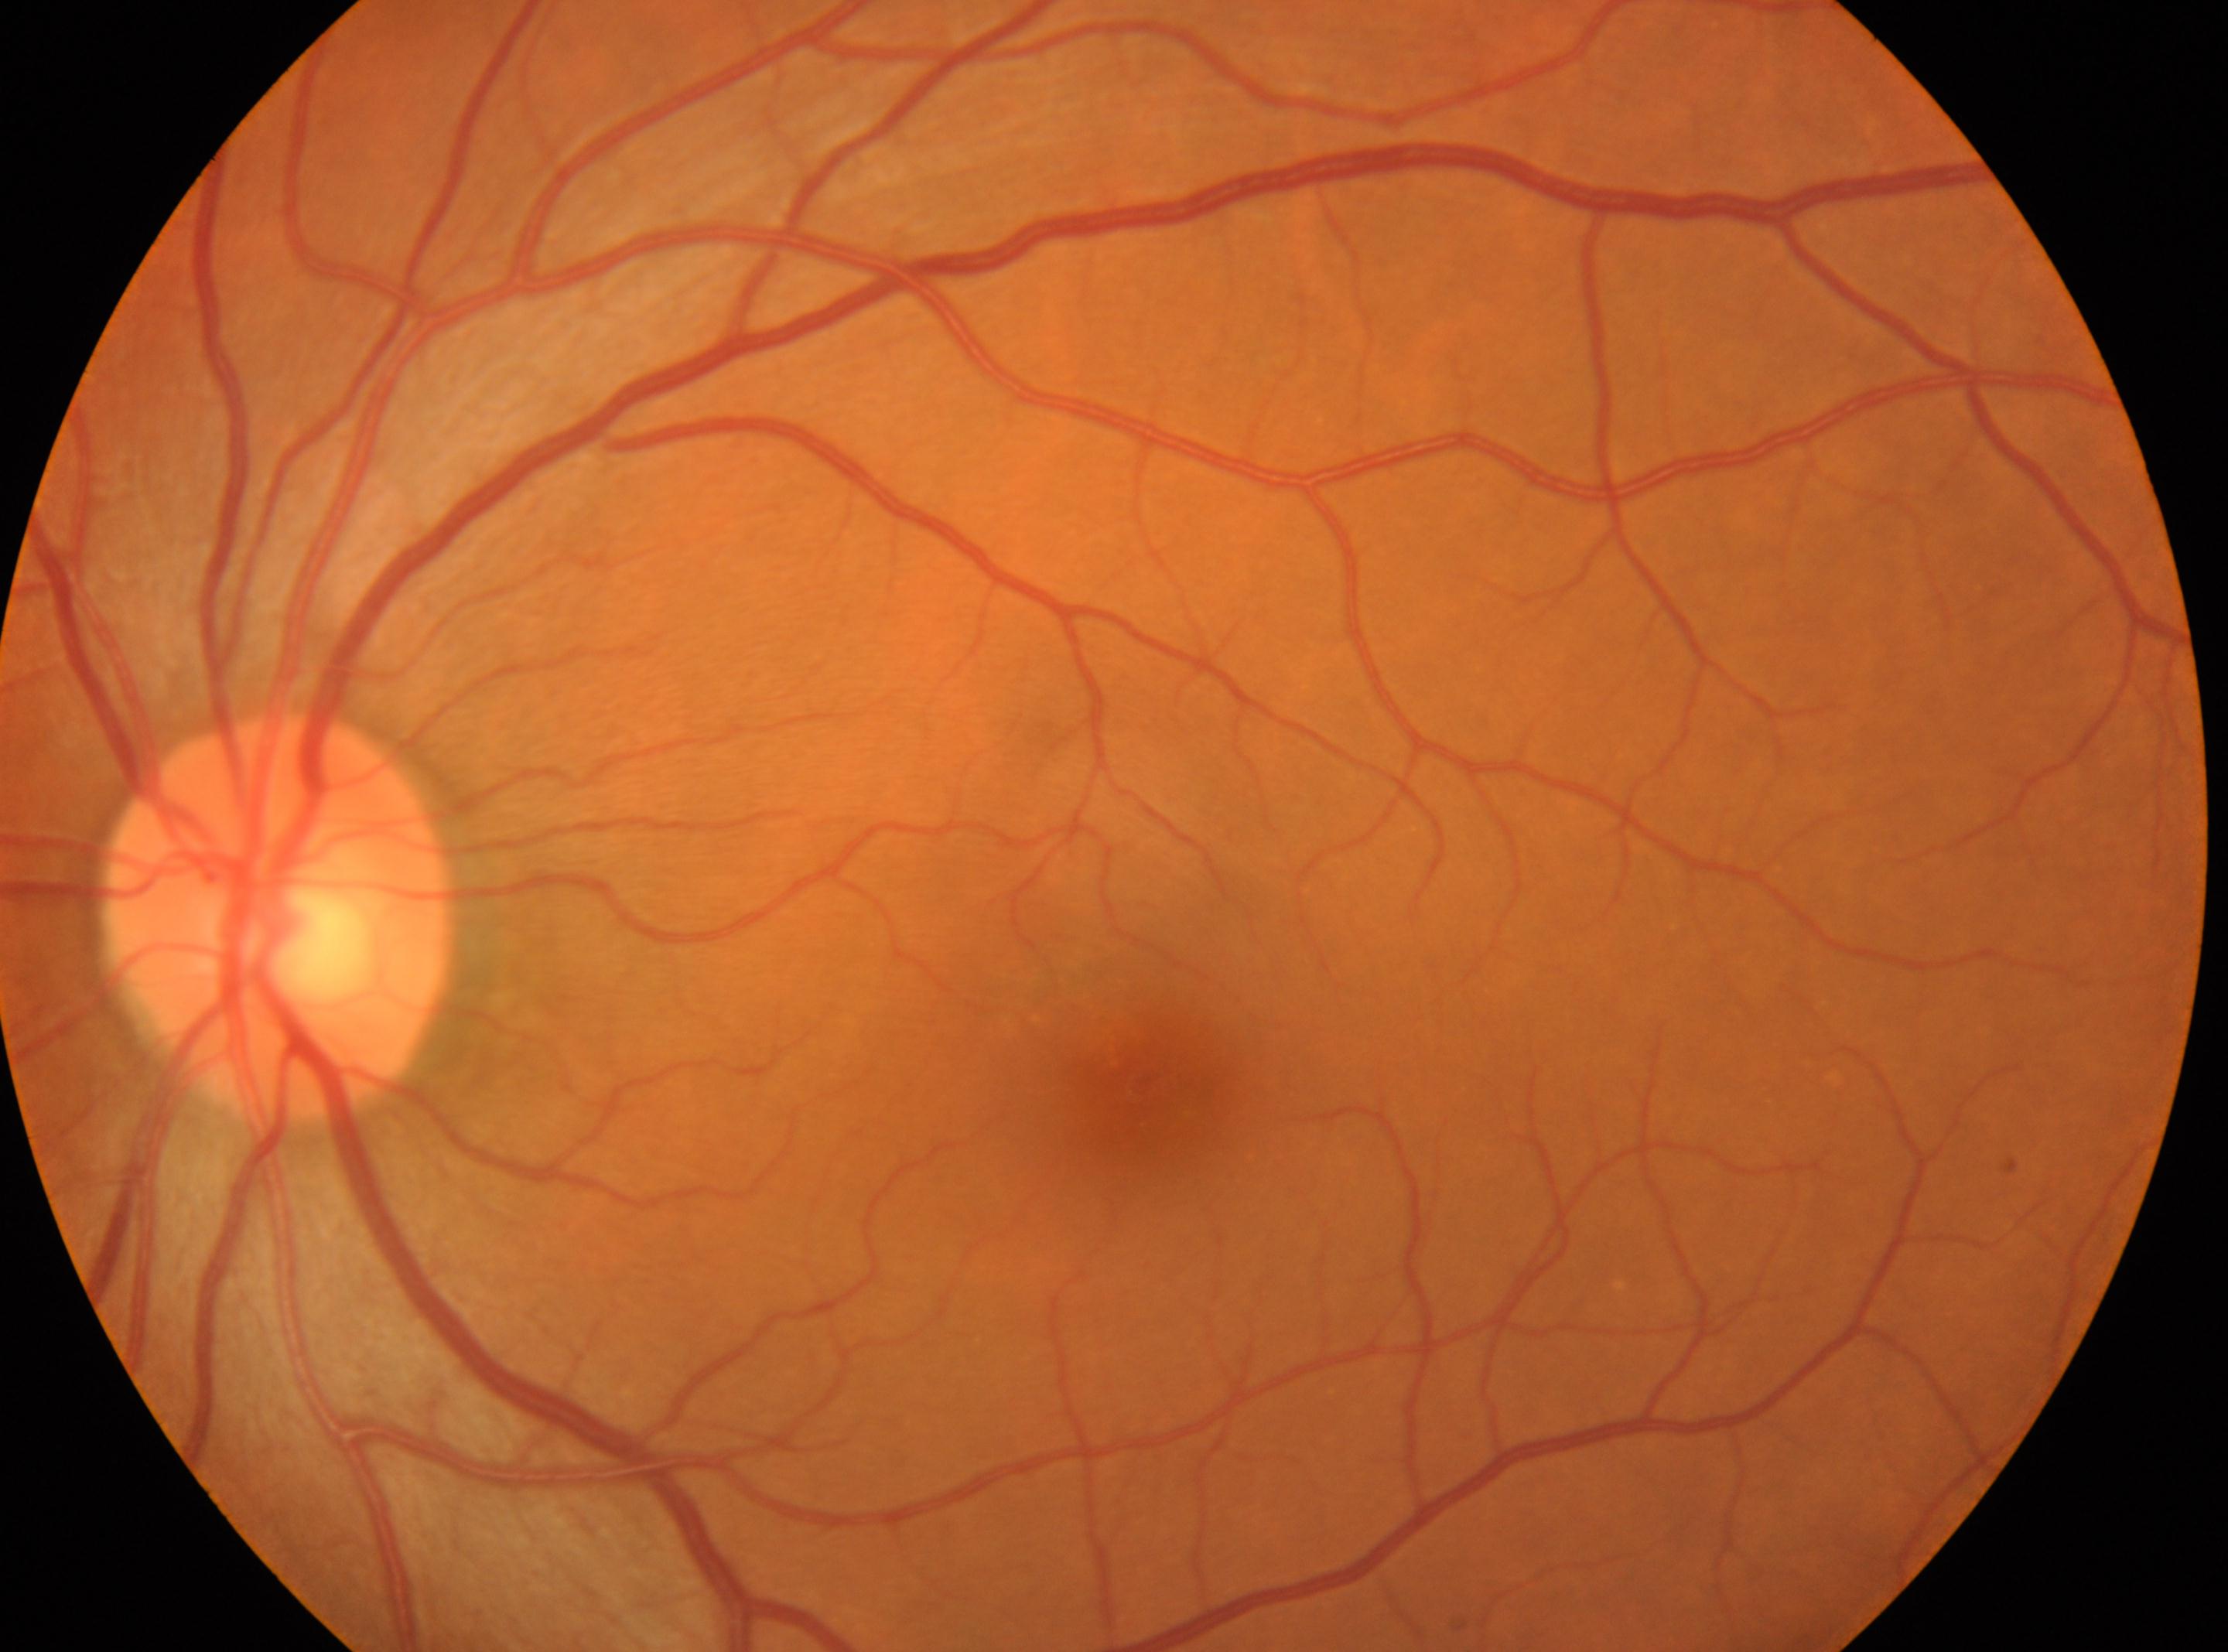

Disc center: (275,917). Fovea located at (1139,1078). The image shows the left eye. No DR findings. Diabetic retinopathy severity is no apparent retinopathy (grade 0).